2212 x 1672 pixels: 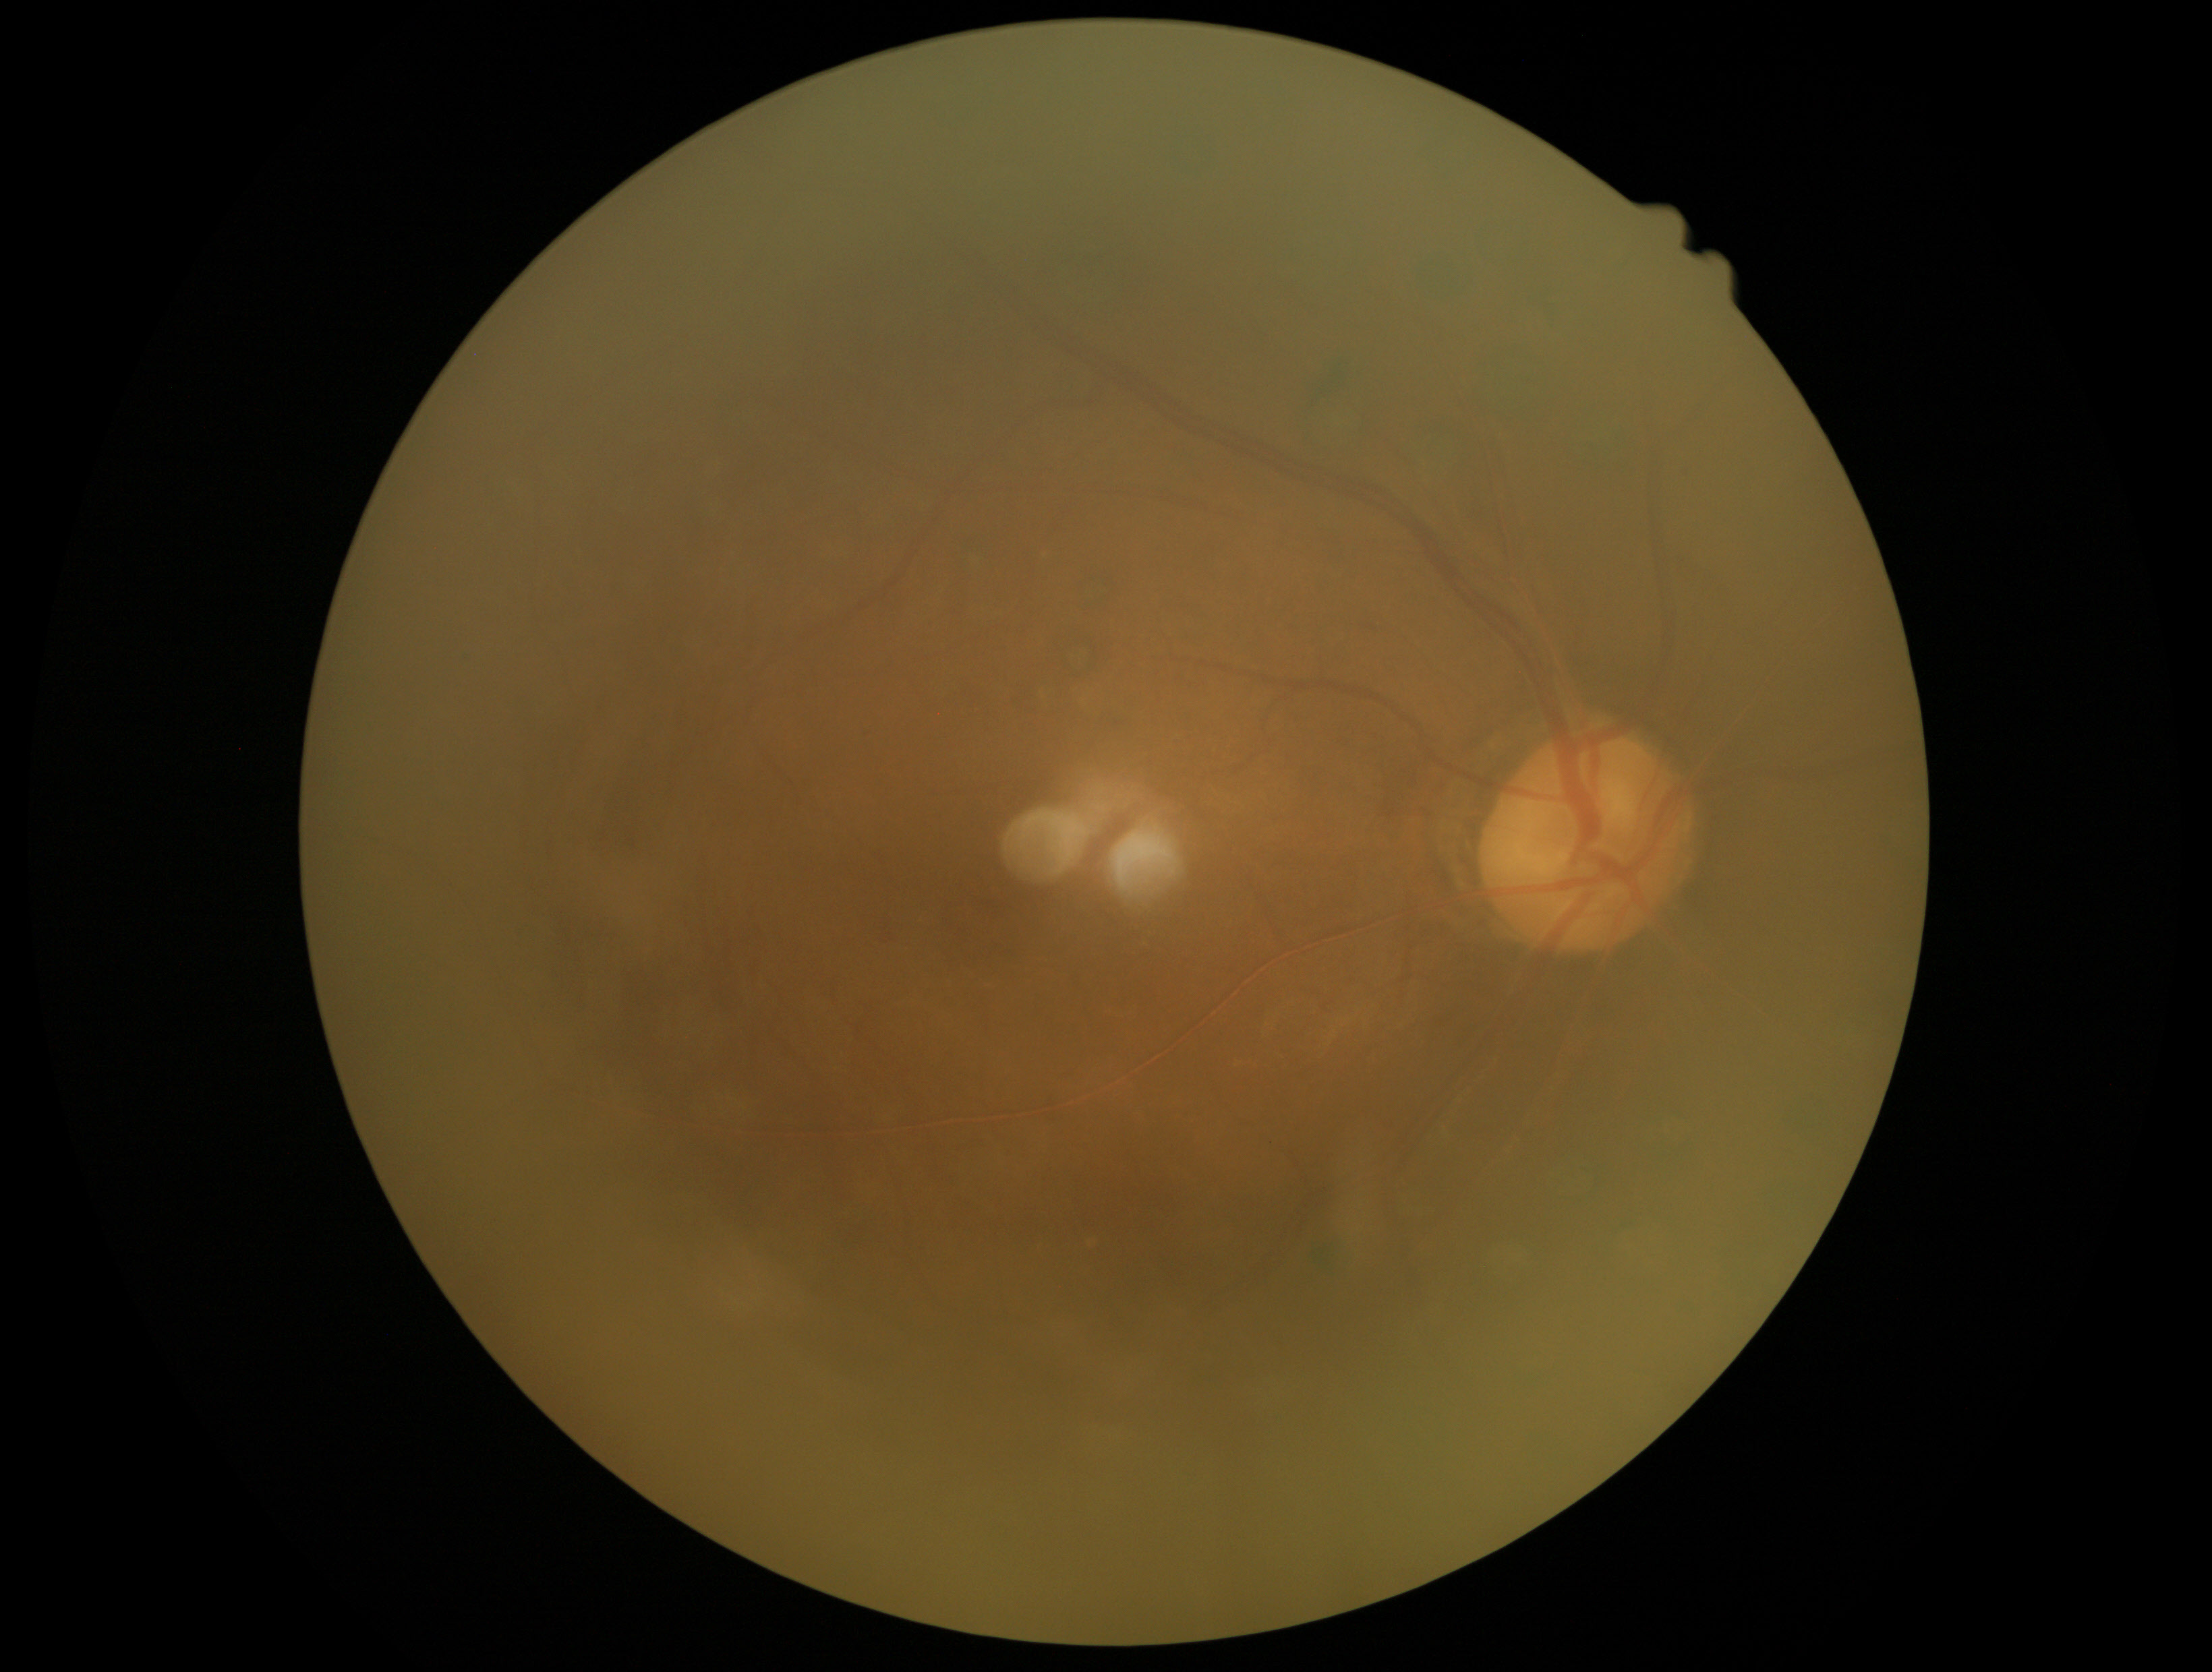

Image quality is insufficient for diabetic retinopathy assessment.
Diabetic retinopathy (DR): ungradable due to poor image quality.